Pediatric wide-field fundus photograph: 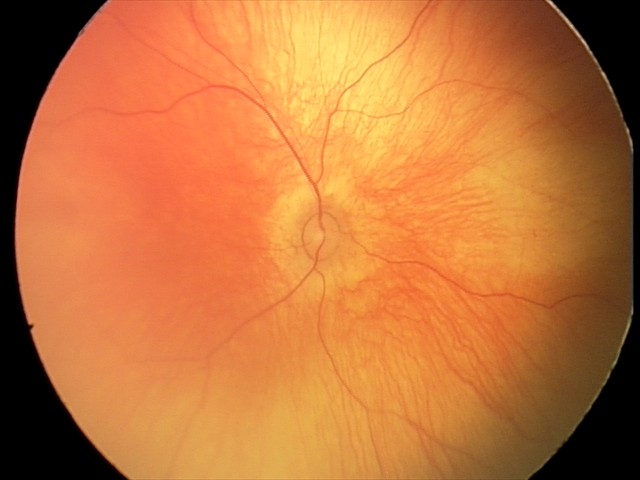

Screening examination with no abnormal retinal findings.